848x848: 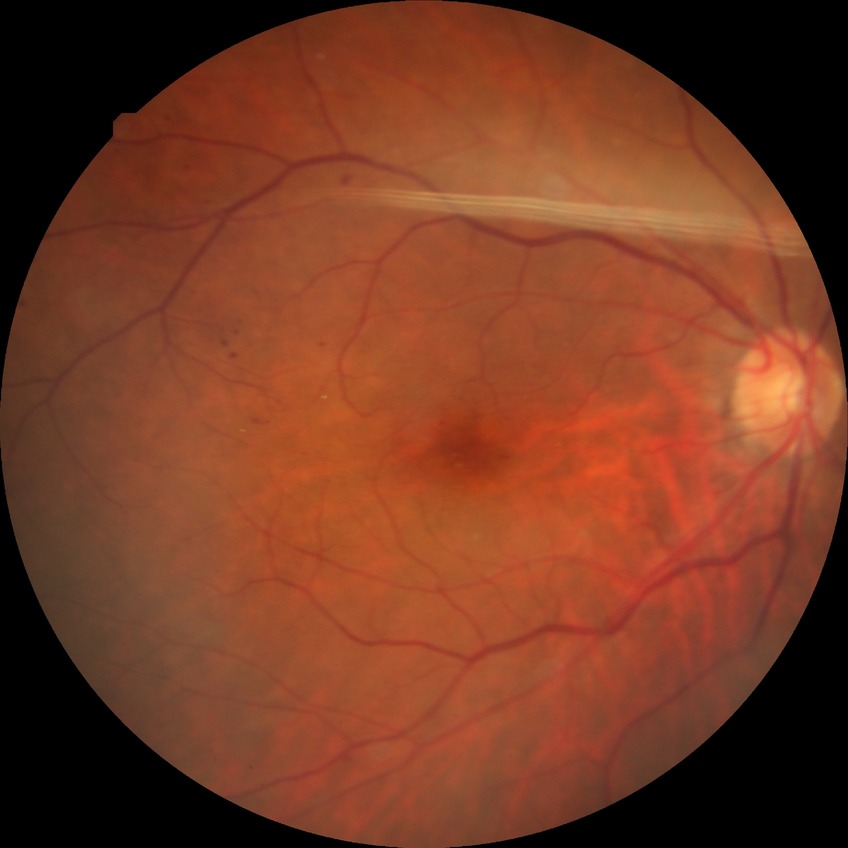
{
  "davis_grade": "SDR (simple diabetic retinopathy)",
  "proliferative_class": "non-proliferative diabetic retinopathy"
}